1924 x 1556 pixels; ultra-widefield fundus mosaic; 200° field of view — 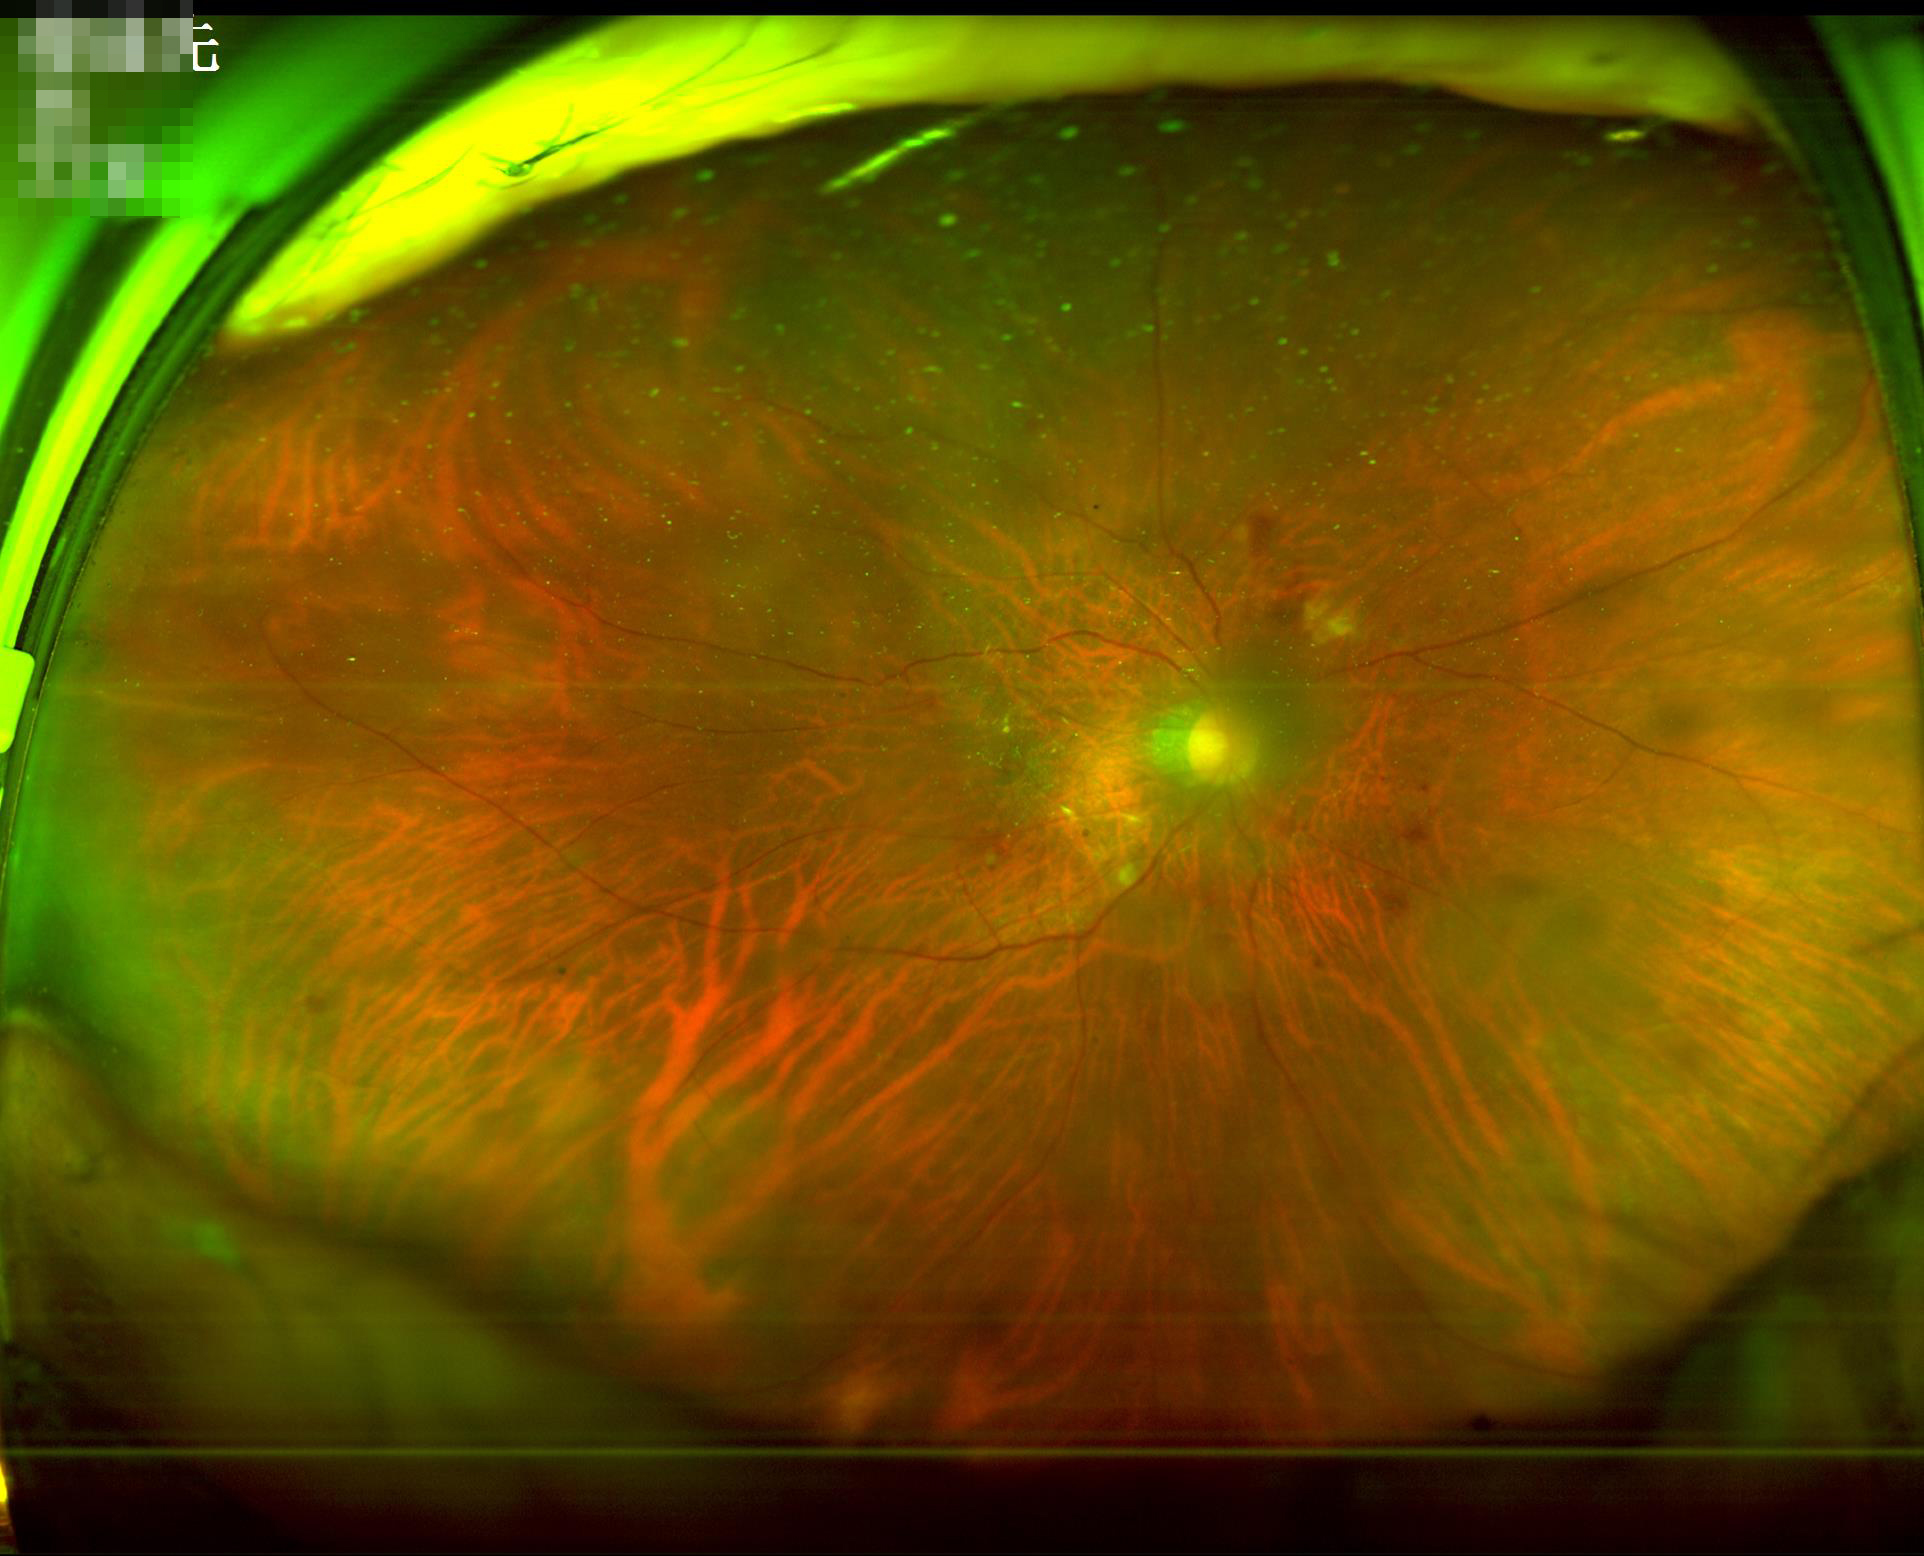 Illumination/color = satisfactory; Contrast = adequate; Sharpness = blurry; Overall image quality = low.